100° field of view (Phoenix ICON) · infant wide-field fundus photograph — 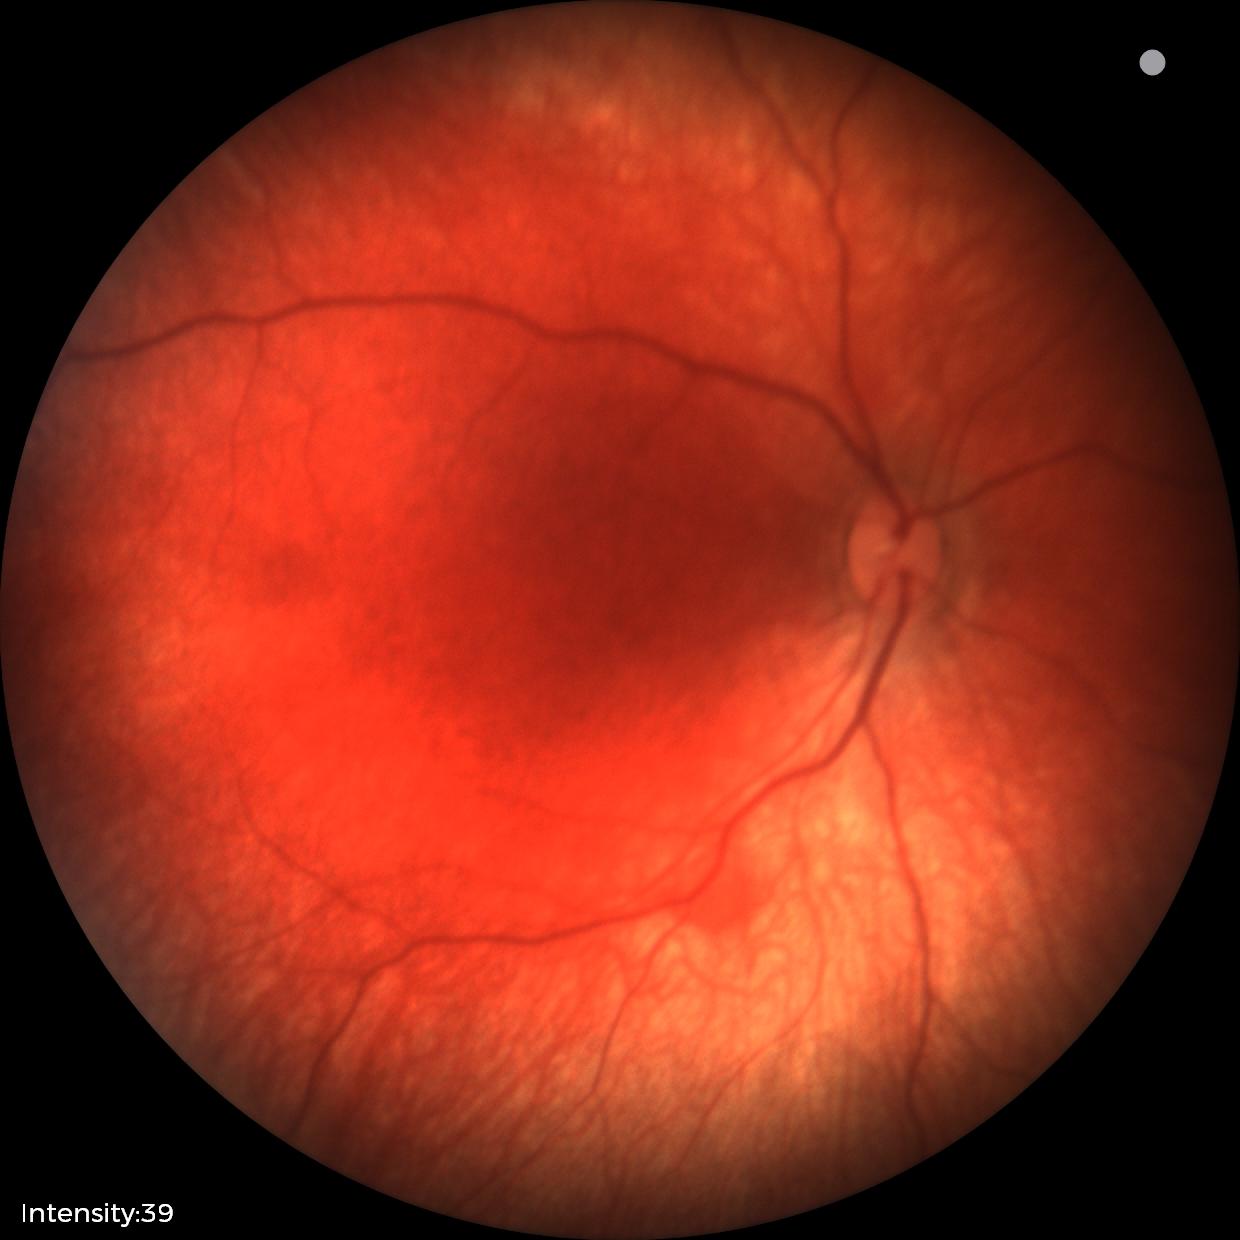 Impression: retinal hemorrhages.